Nonmydriatic fundus photograph; fundus photo; modified Davis classification — 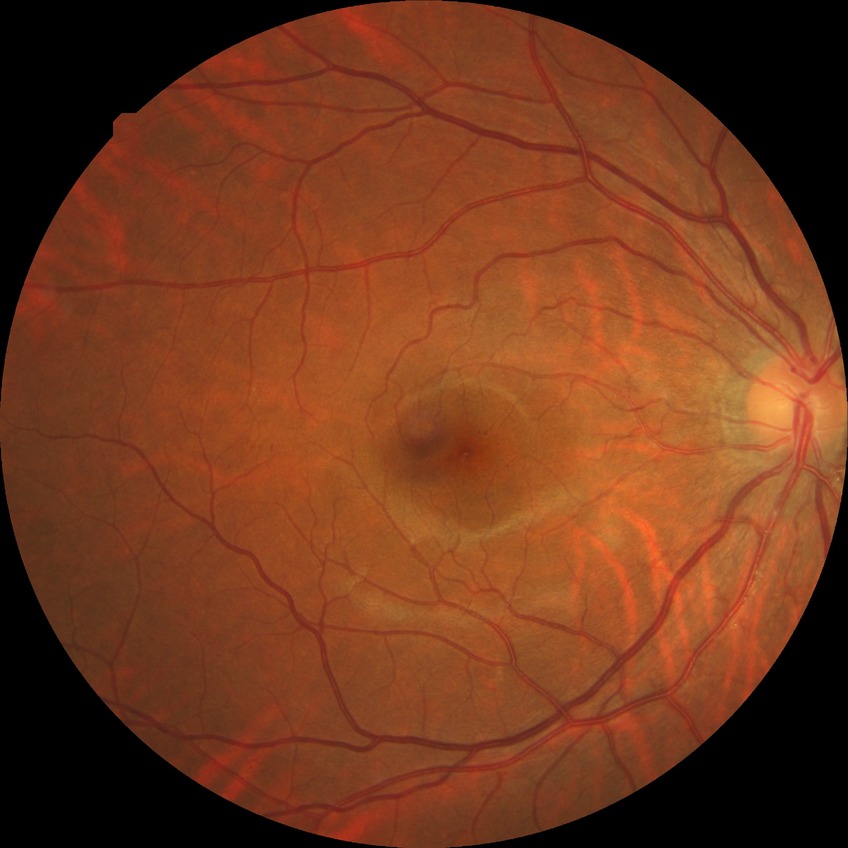 No apparent diabetic retinopathy.
Davis DR grade is NDR.